Diabetic retinopathy graded by the modified Davis classification — 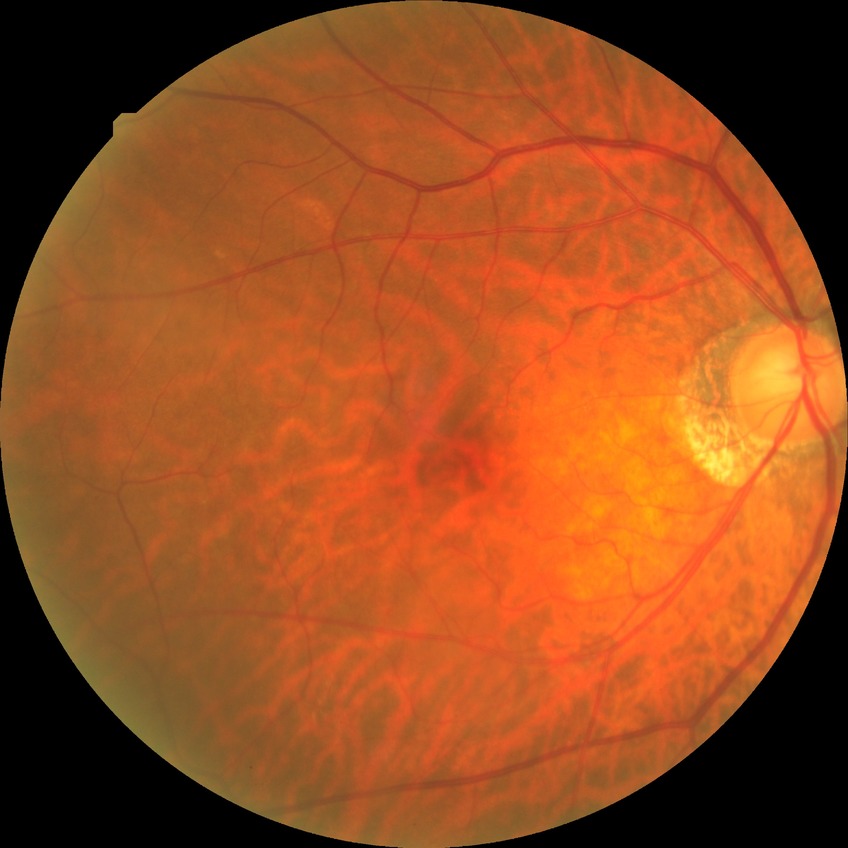
Diabetic retinopathy stage is no diabetic retinopathy.